Portable fundus photograph
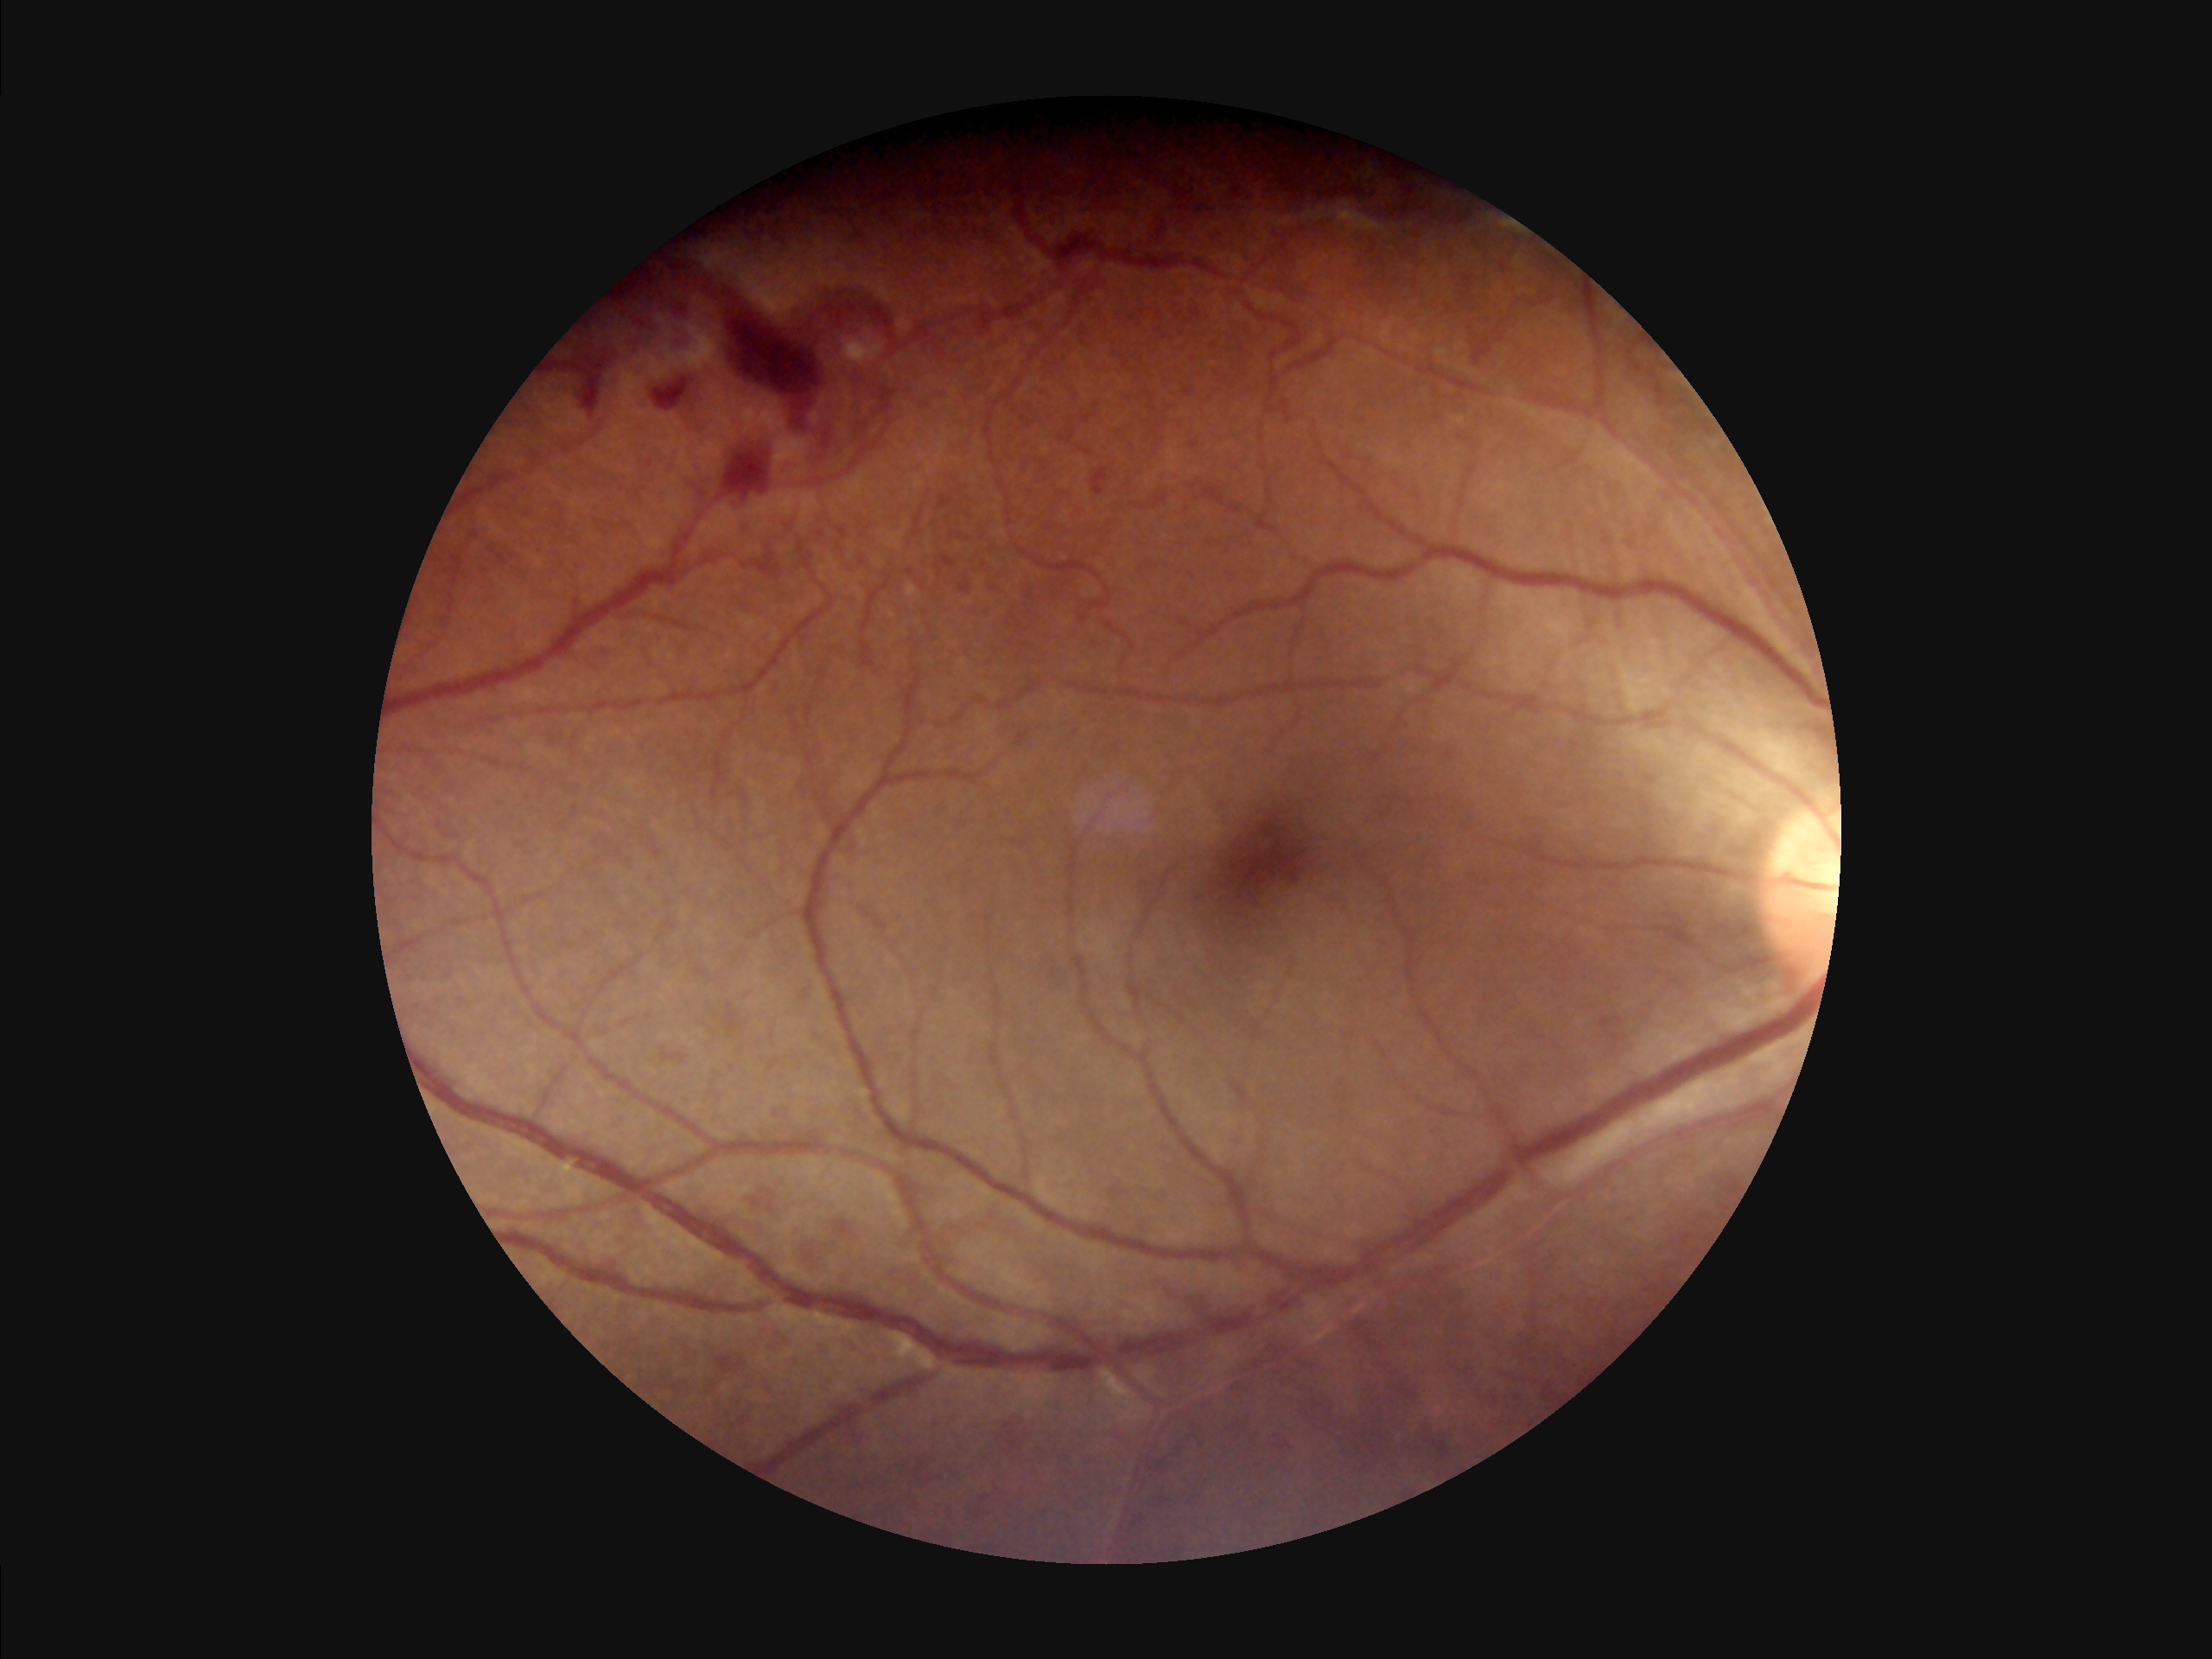
The image is clear. Overall image quality is good.